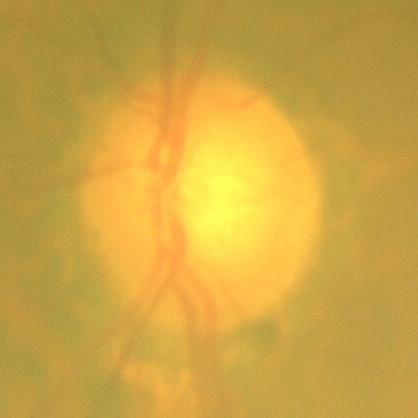 The image shows no glaucoma.